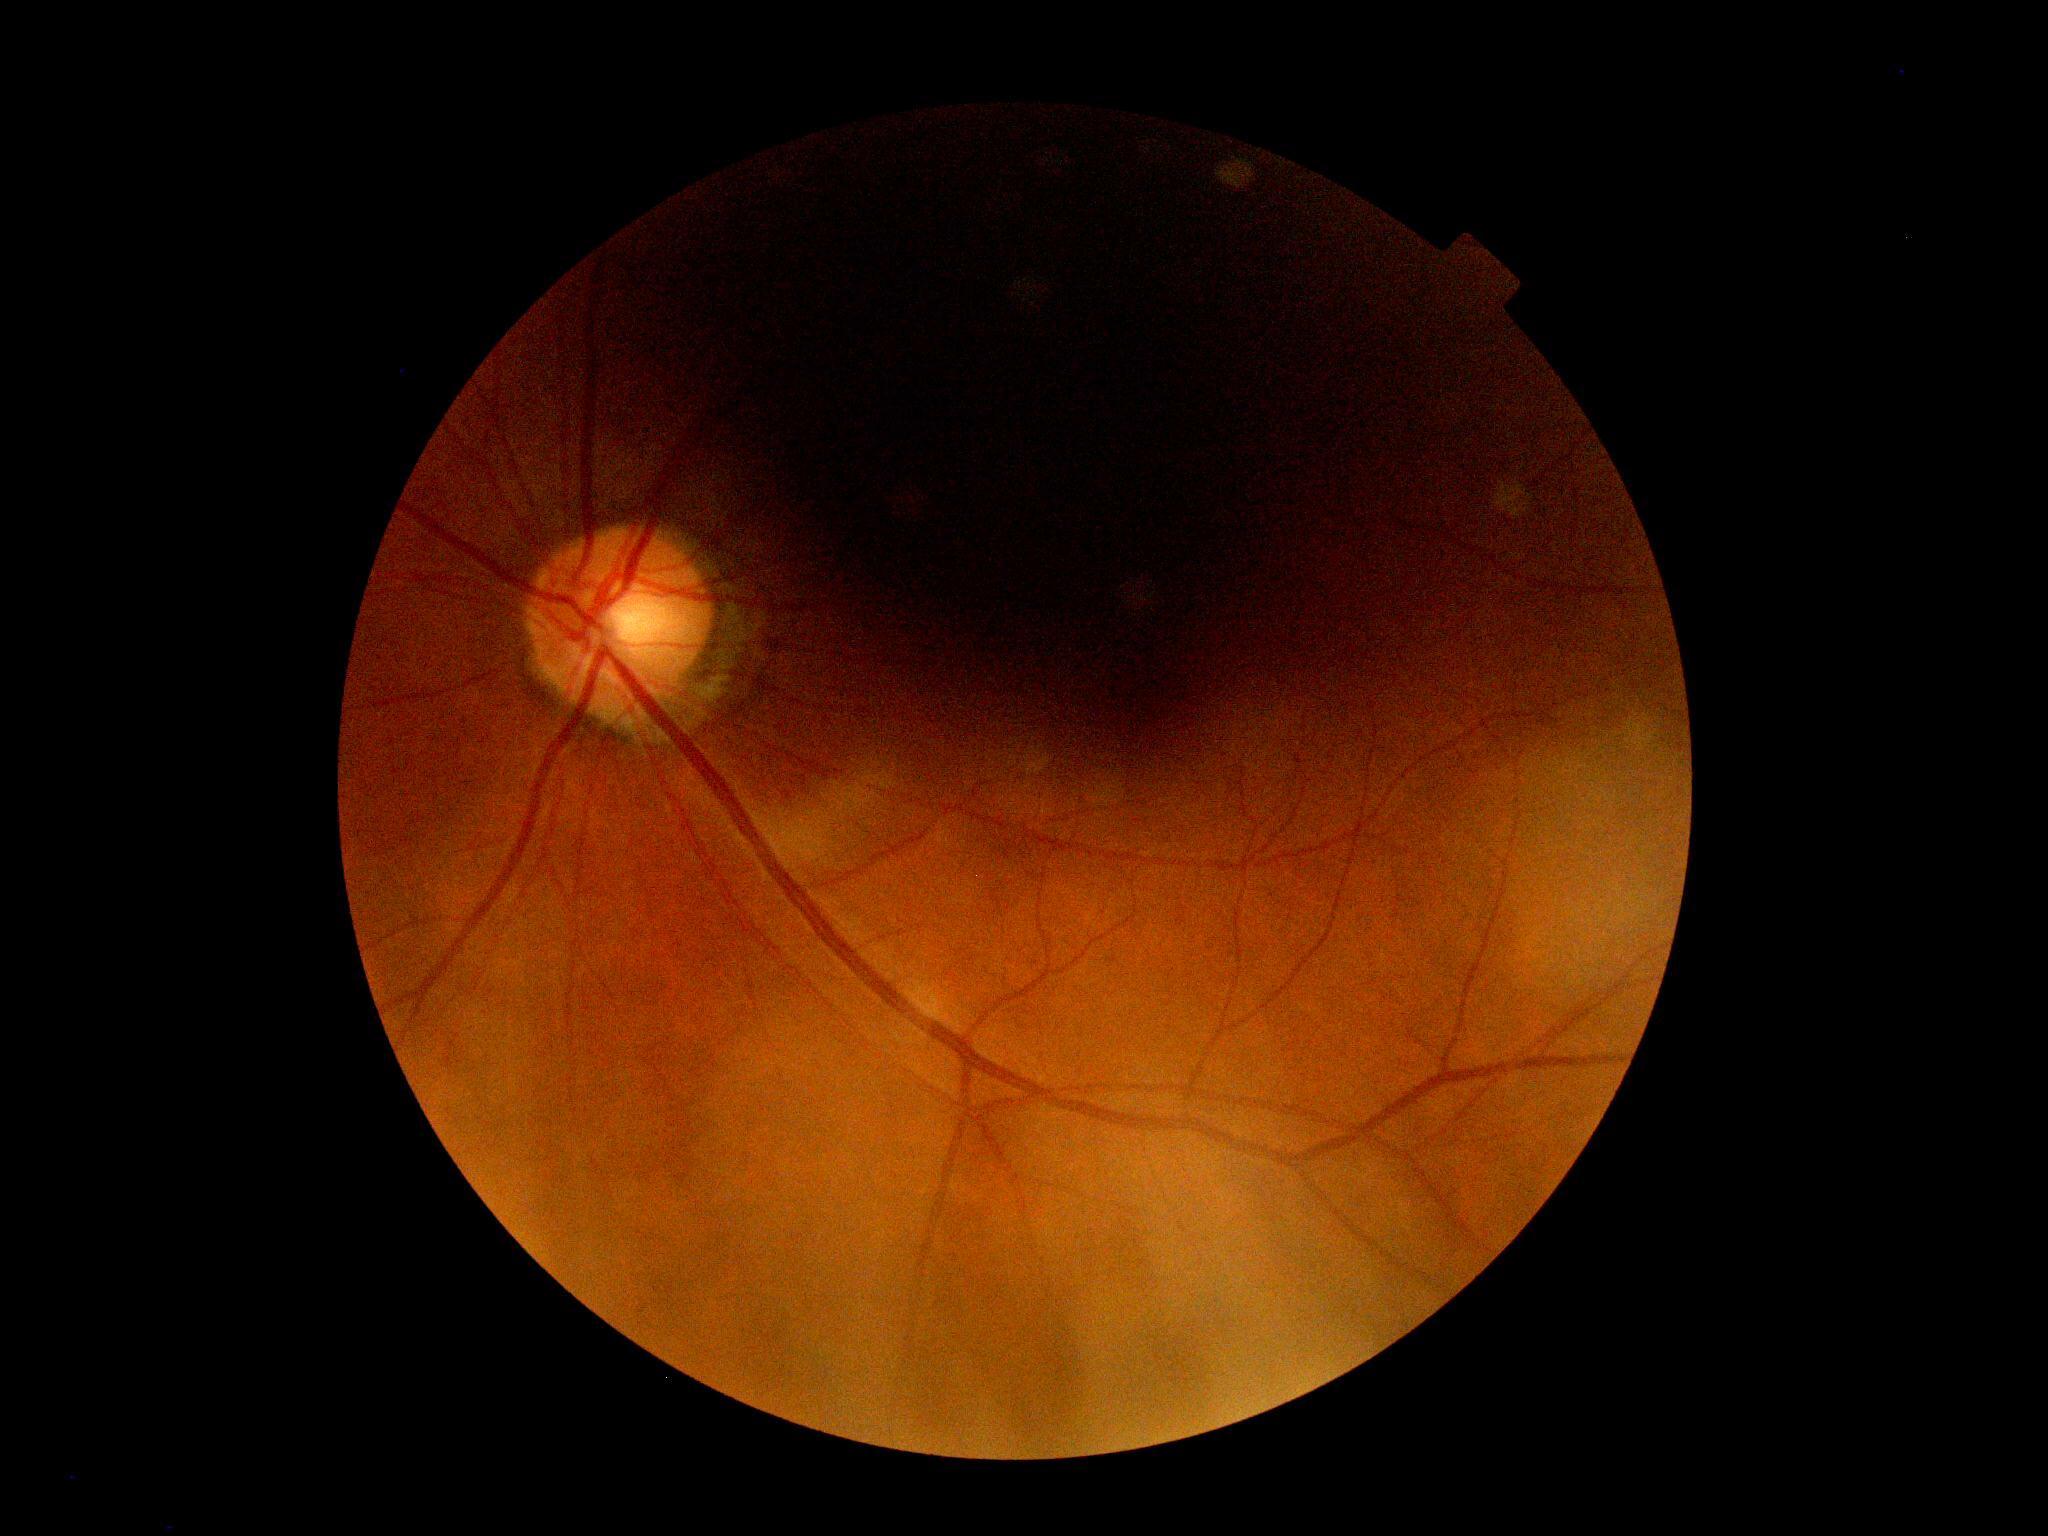 Diabetic retinopathy (DR): ungradable due to poor image quality.